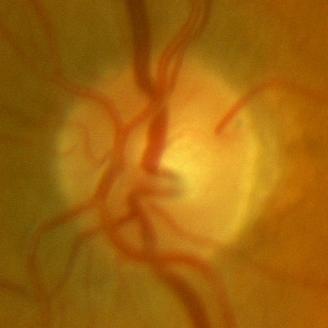

Q: What is the glaucoma diagnosis?
A: No glaucomatous optic neuropathy.